848x848px · no pharmacologic dilation: 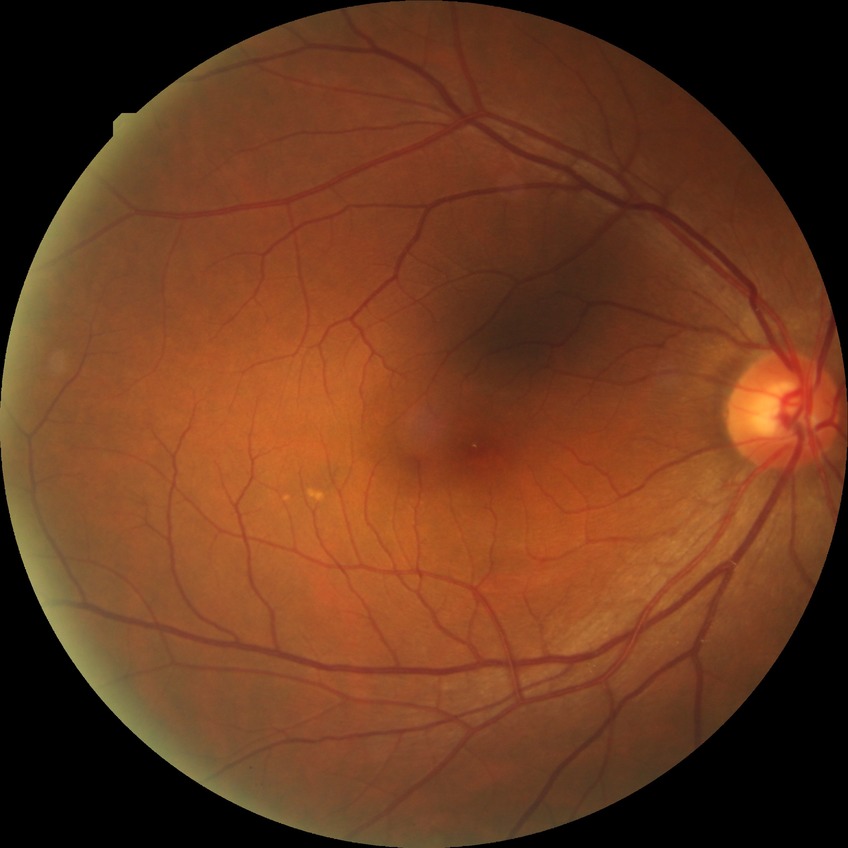 Diabetic retinopathy (DR) is NDR (no diabetic retinopathy).